Infant wide-field fundus photograph. Acquired on the Clarity RetCam 3:
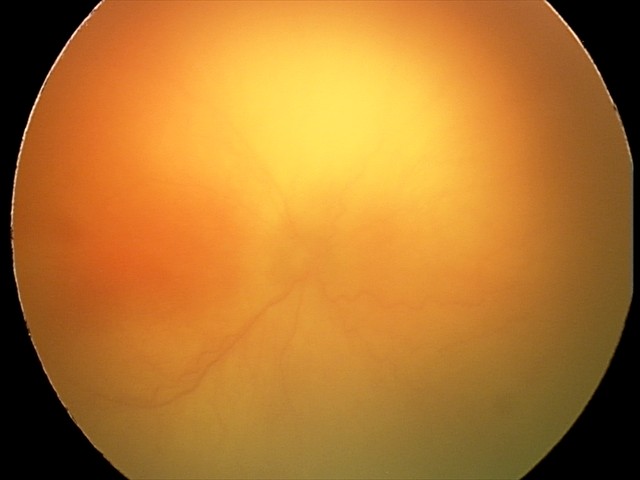 Assessment = A-ROP (aggressive ROP) | plus form = present.